Retinal fundus photograph — 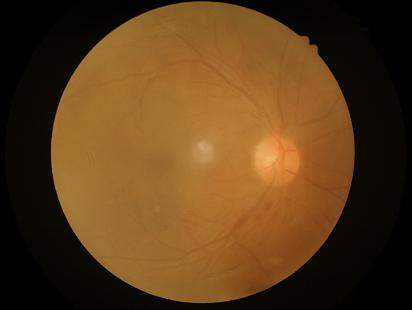
No over- or under-exposure. Reduced sharpness with visible blur. Image quality is suboptimal. Poor dynamic range.